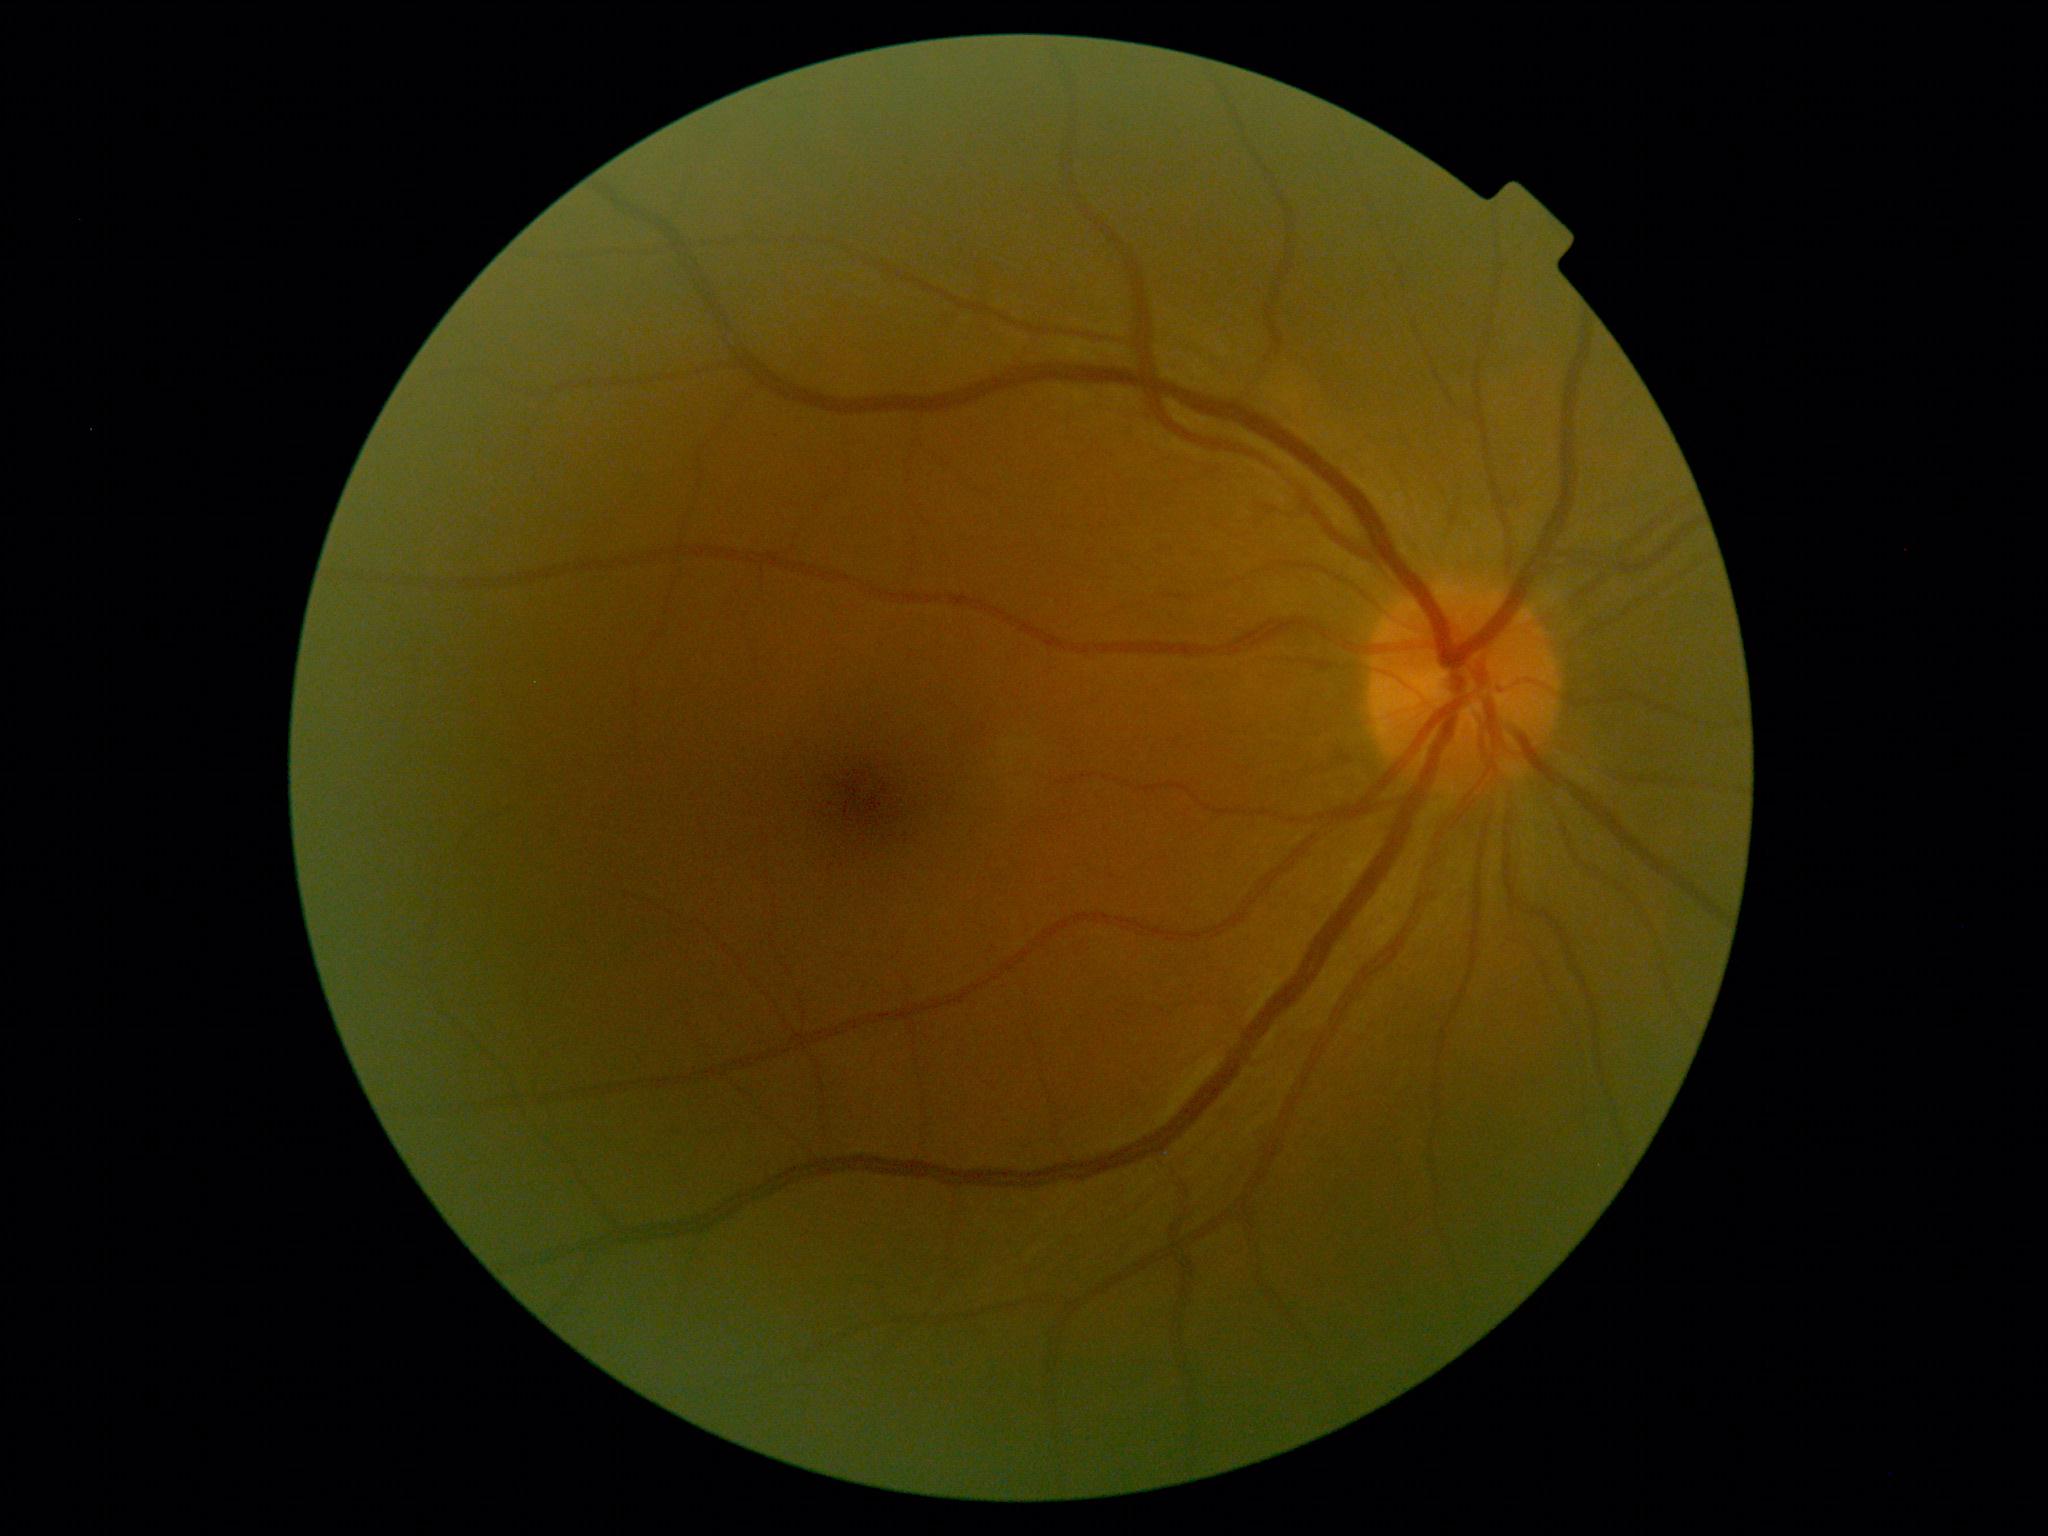 Diabetic retinopathy severity is grade 0 (no apparent retinopathy).